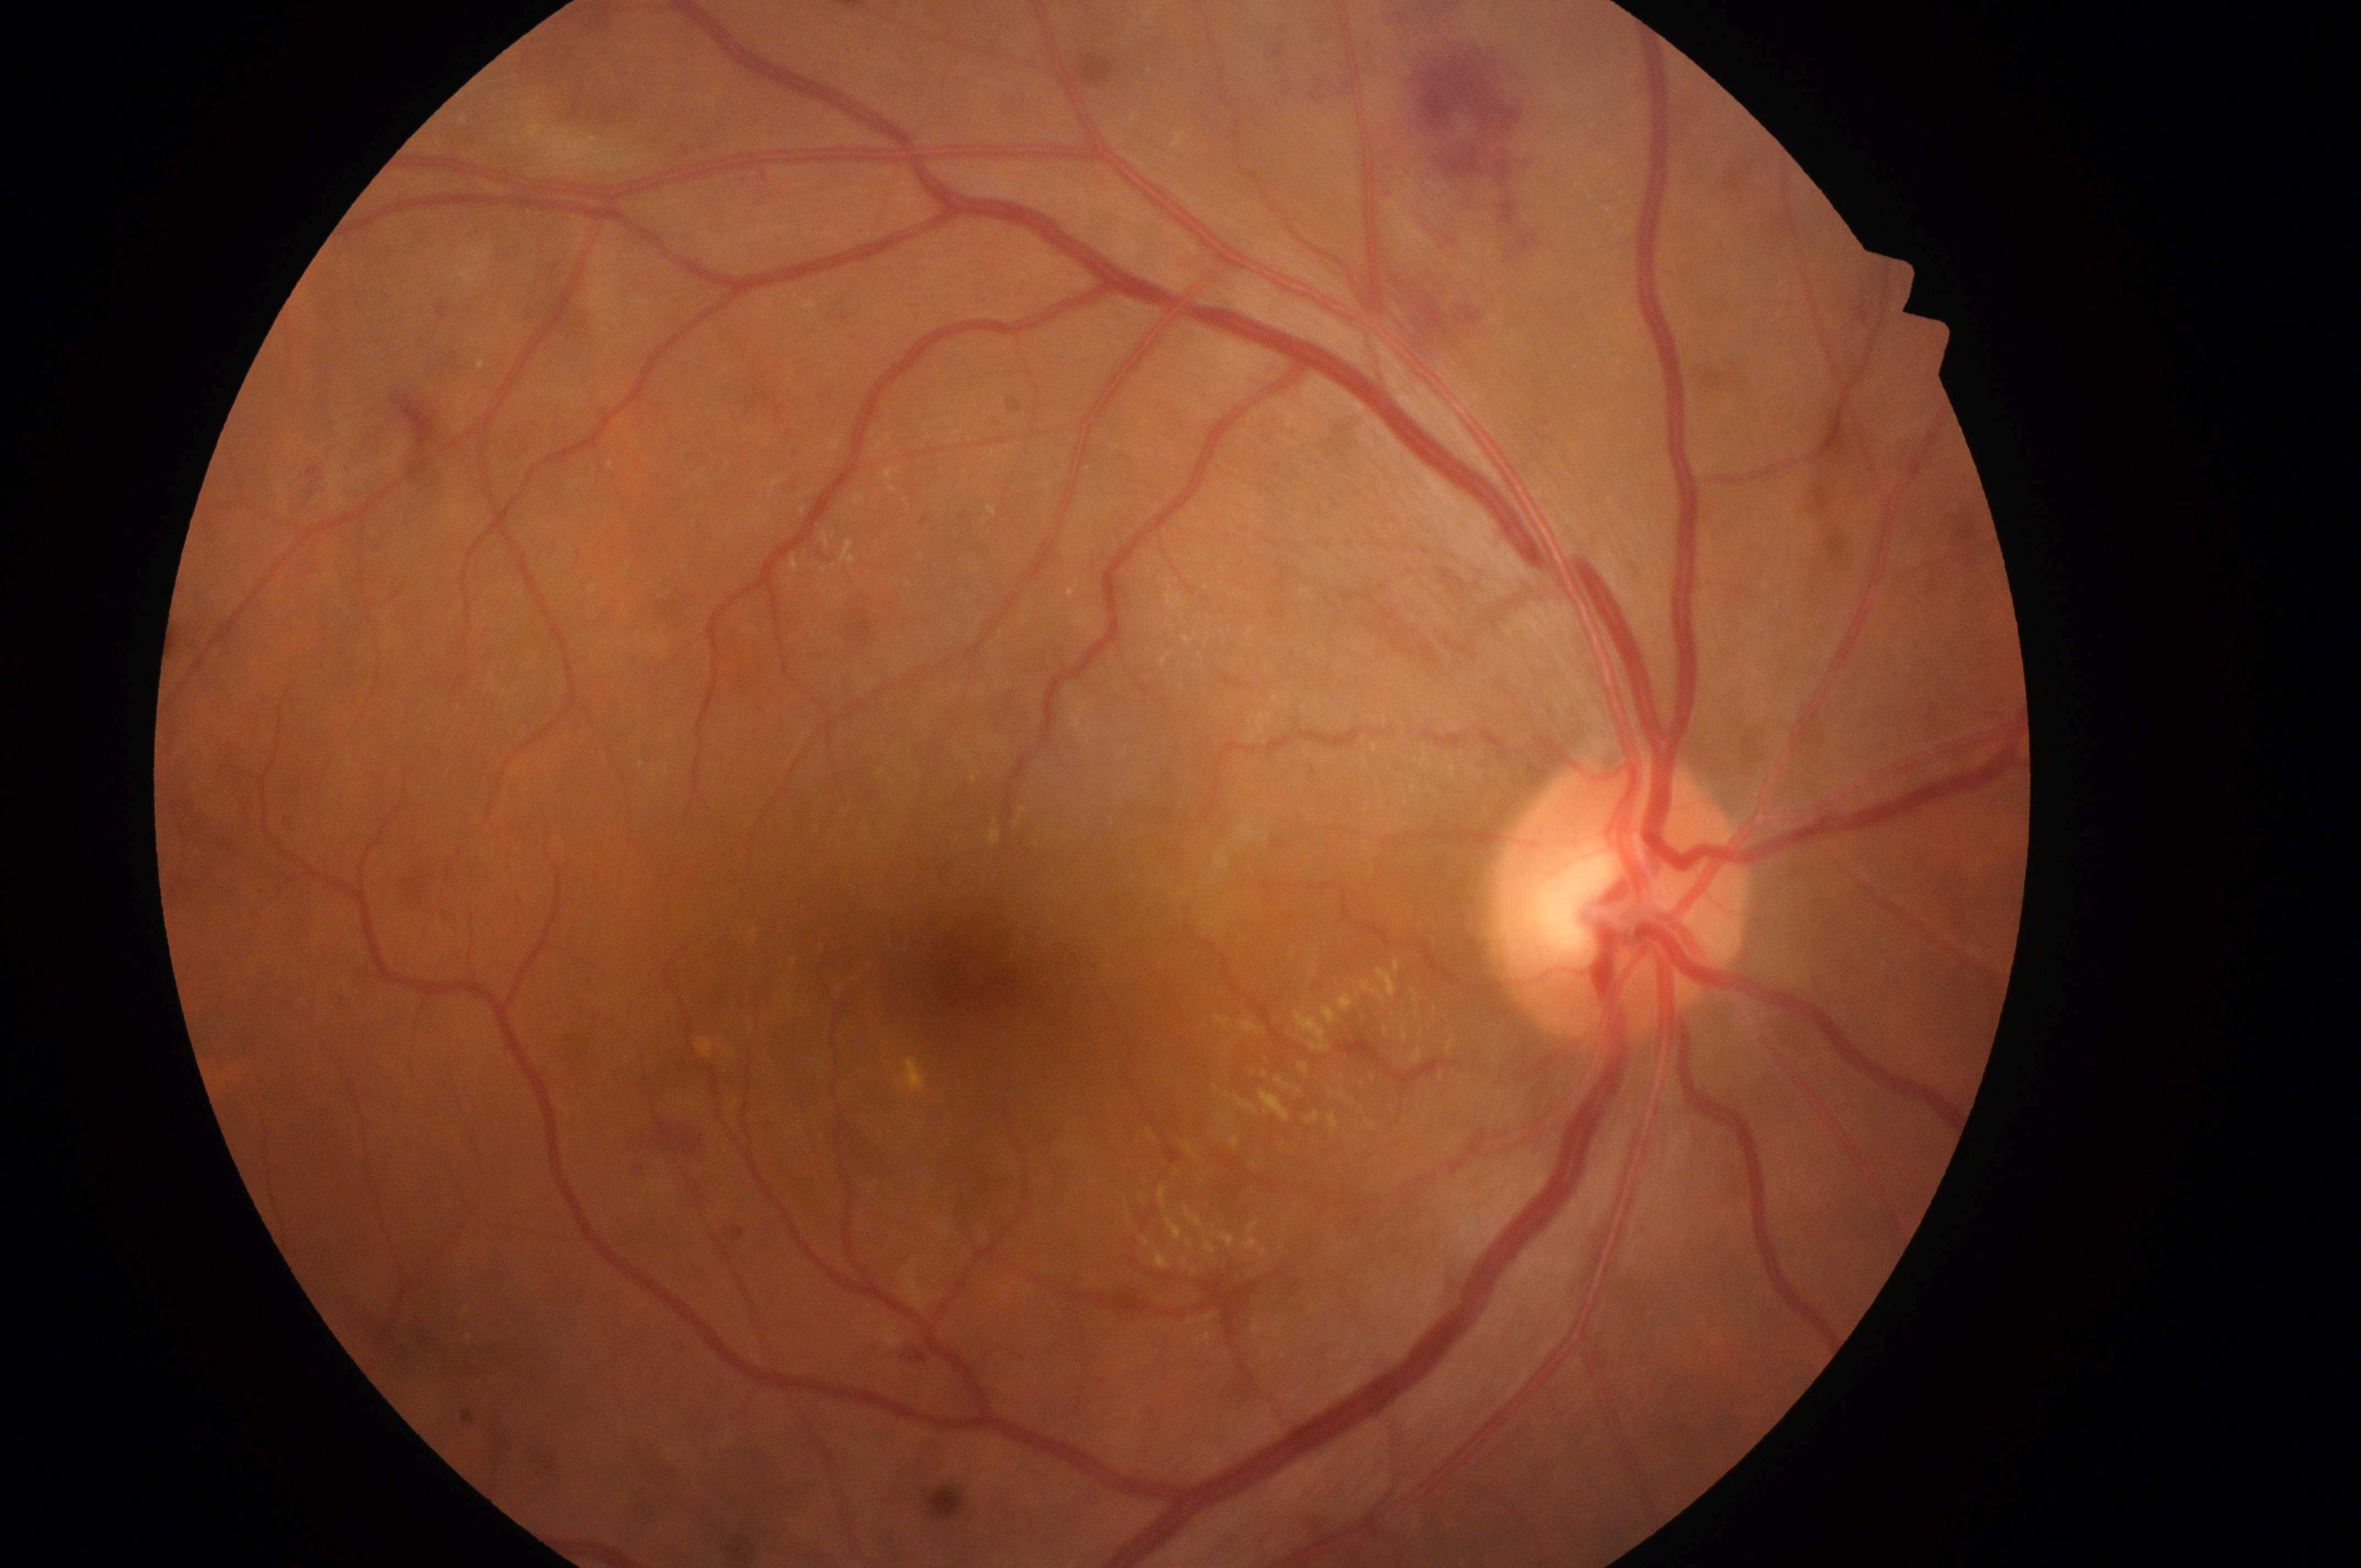
The ONH is at x=1623, y=911. Eye: oculus dexter. DME grade: 2 (high risk). DR grade is moderate non-proliferative diabetic retinopathy (2). Fovea centralis located at x=973, y=975.